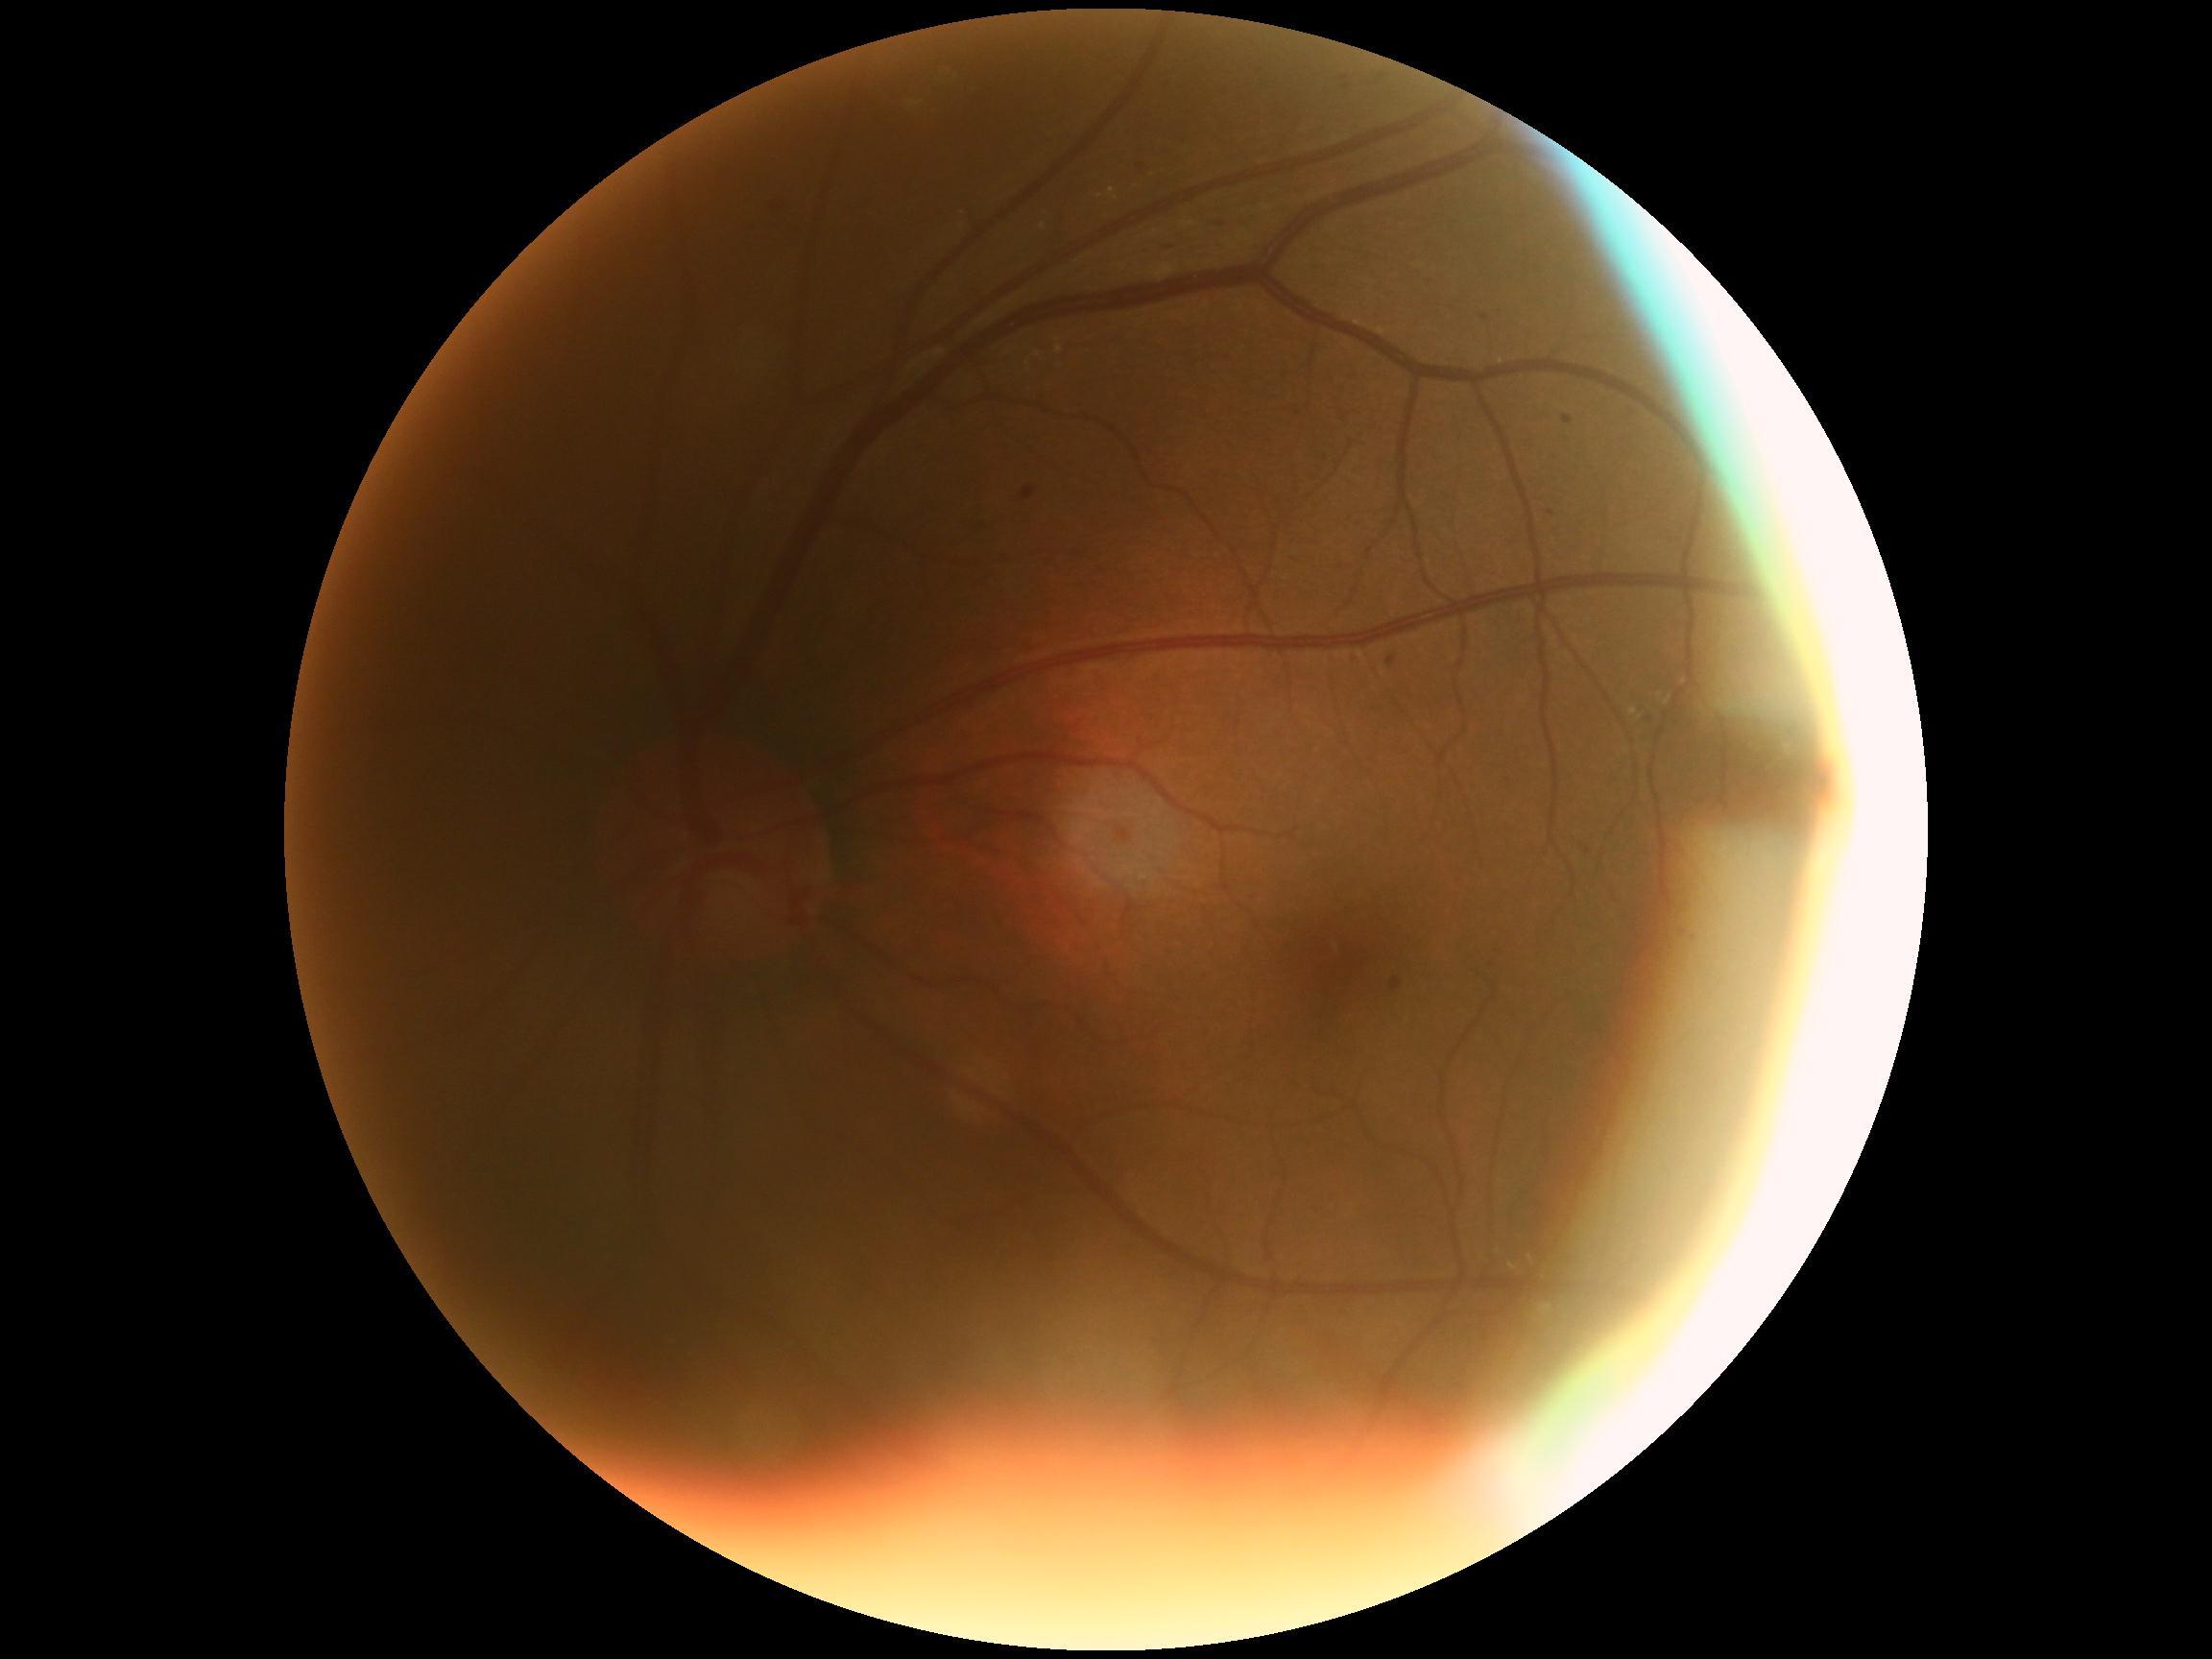
Diabetic retinopathy (DR) is moderate non-proliferative diabetic retinopathy (grade 2).